Acquired with a NIDEK AFC-230:
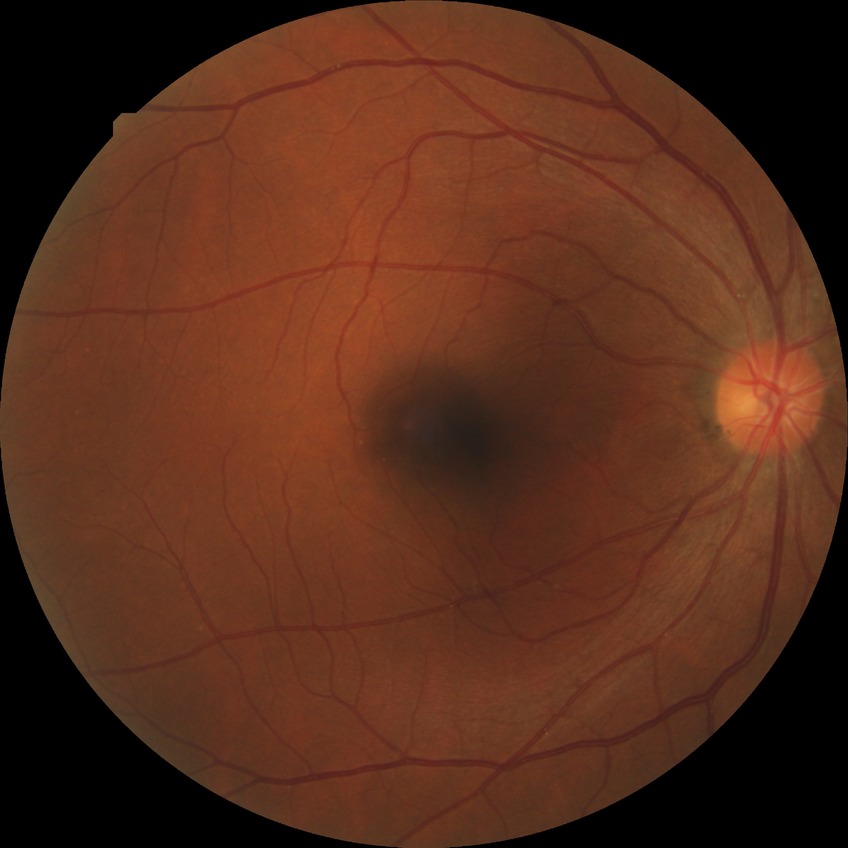

diabetic retinopathy (DR): NDR (no diabetic retinopathy).